45-degree field of view
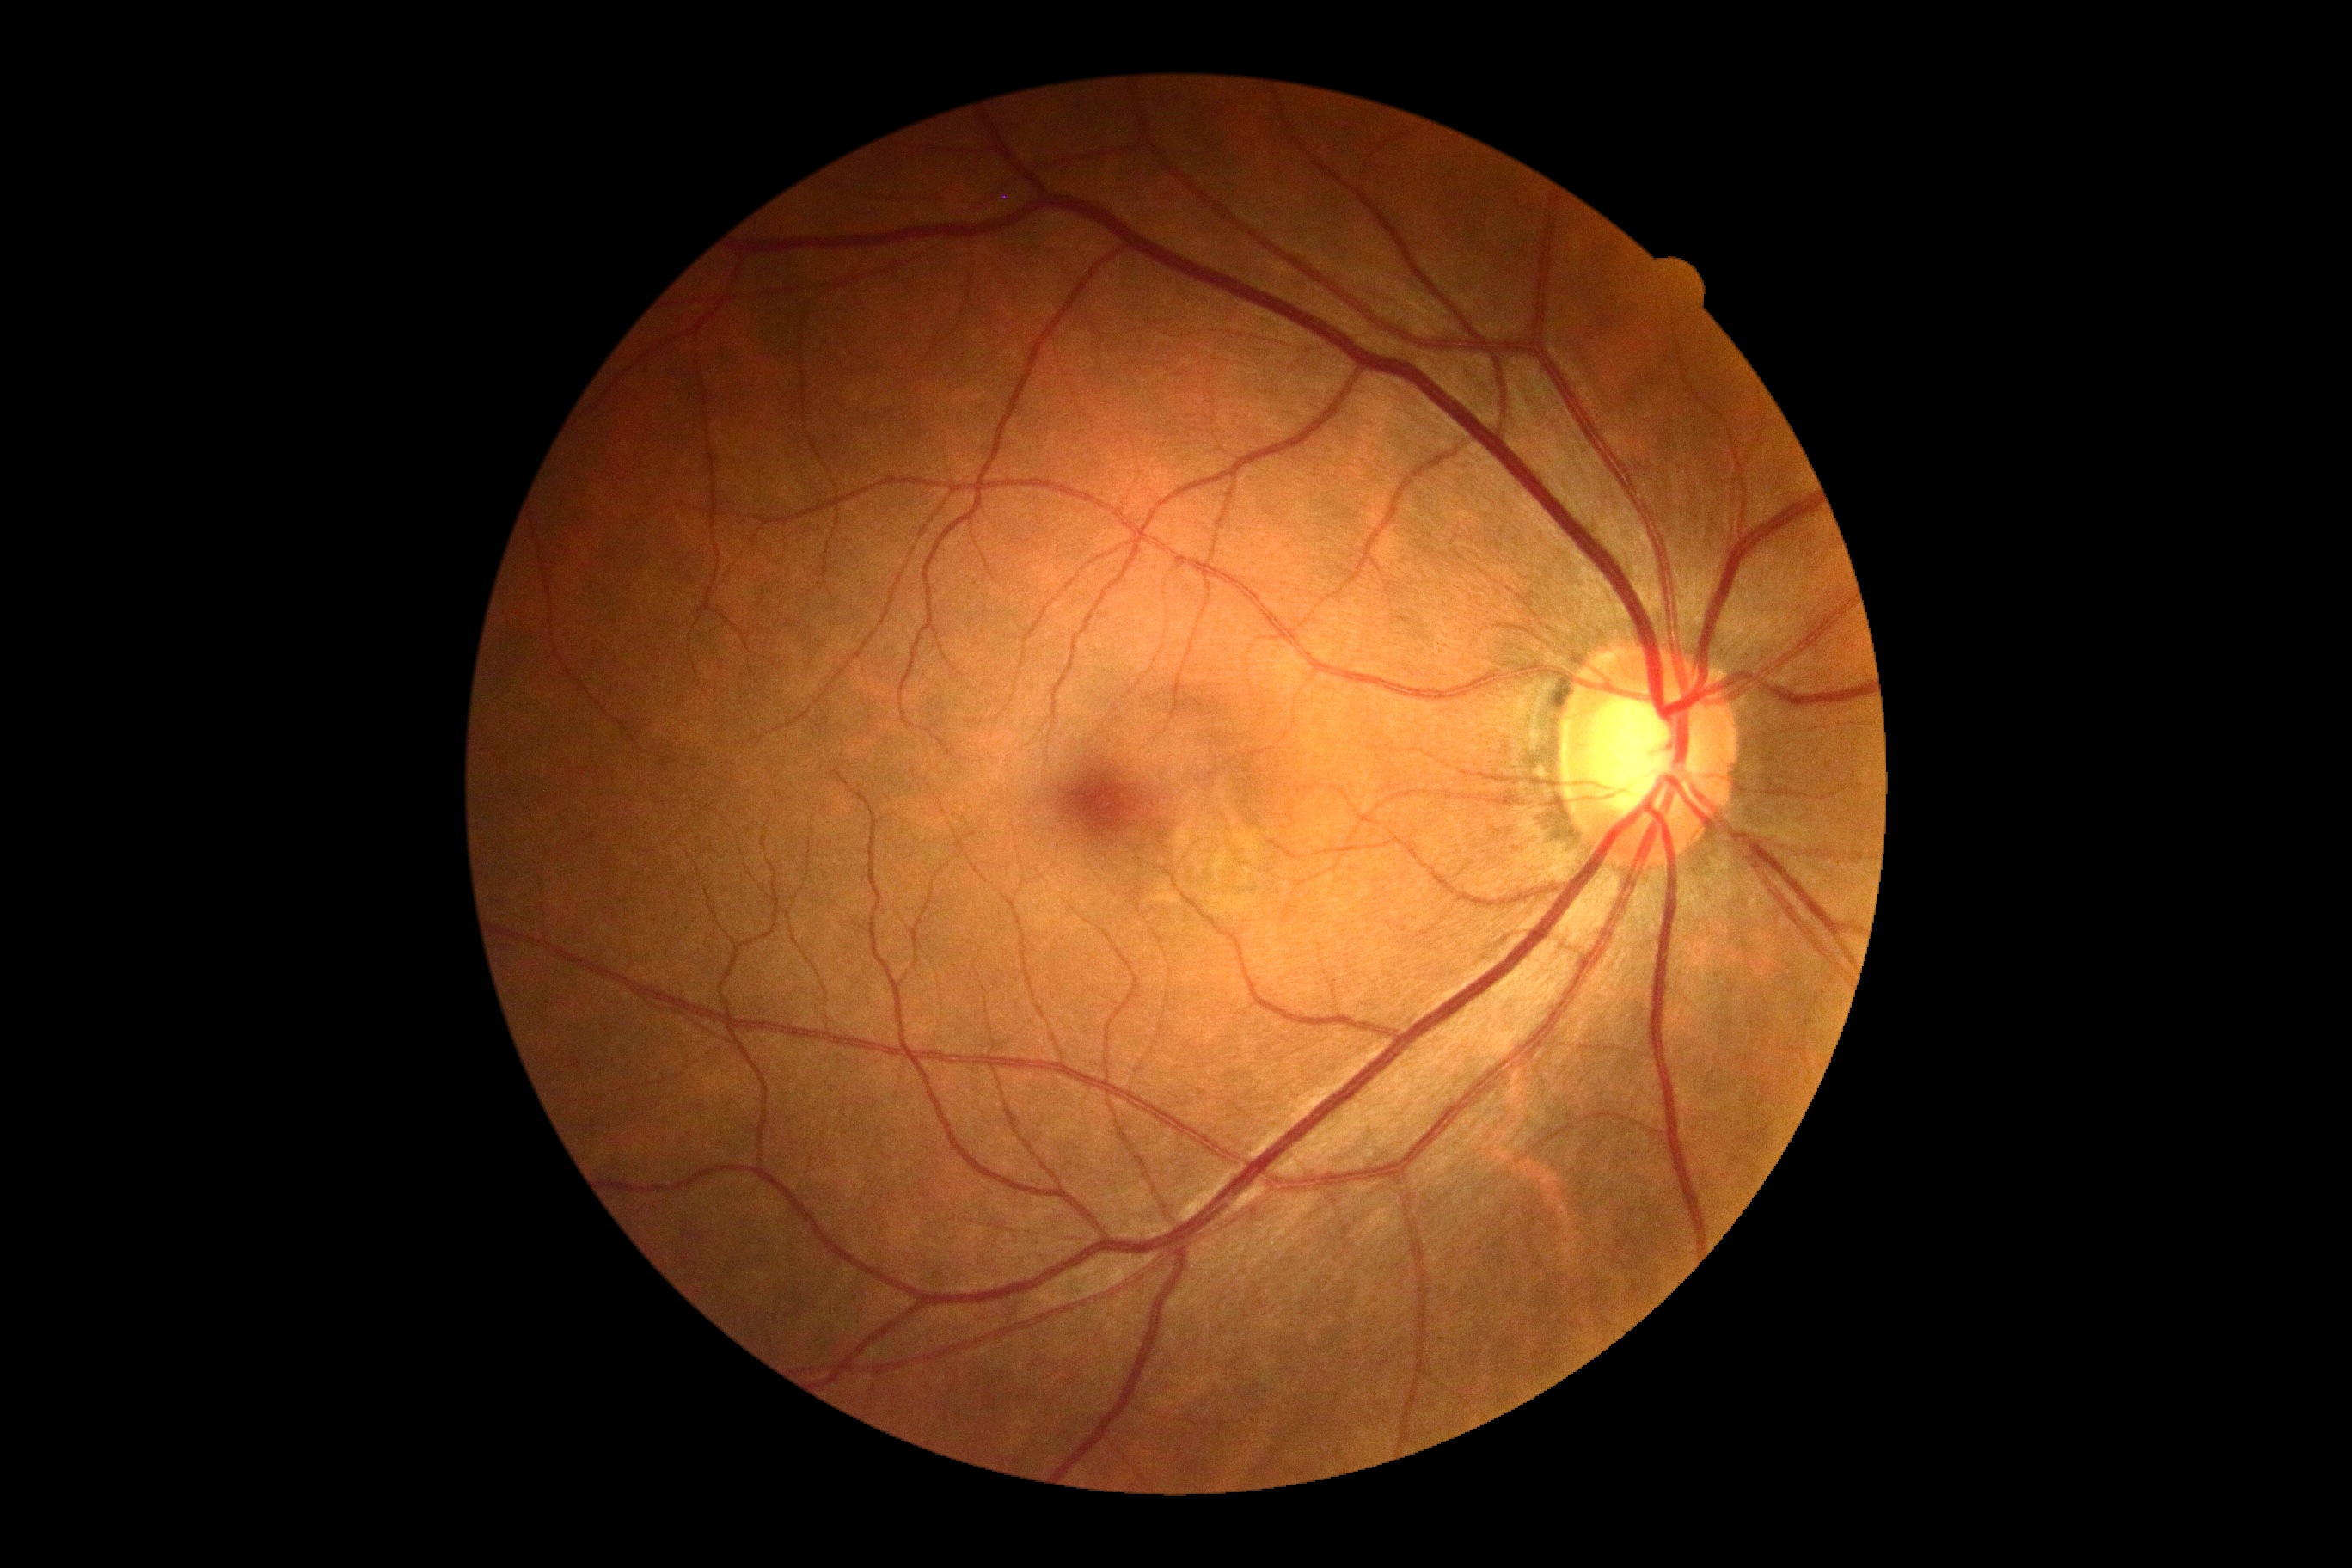
DR impression: no DR findings
DR: grade 0 (no apparent retinopathy)